2212x1659 — 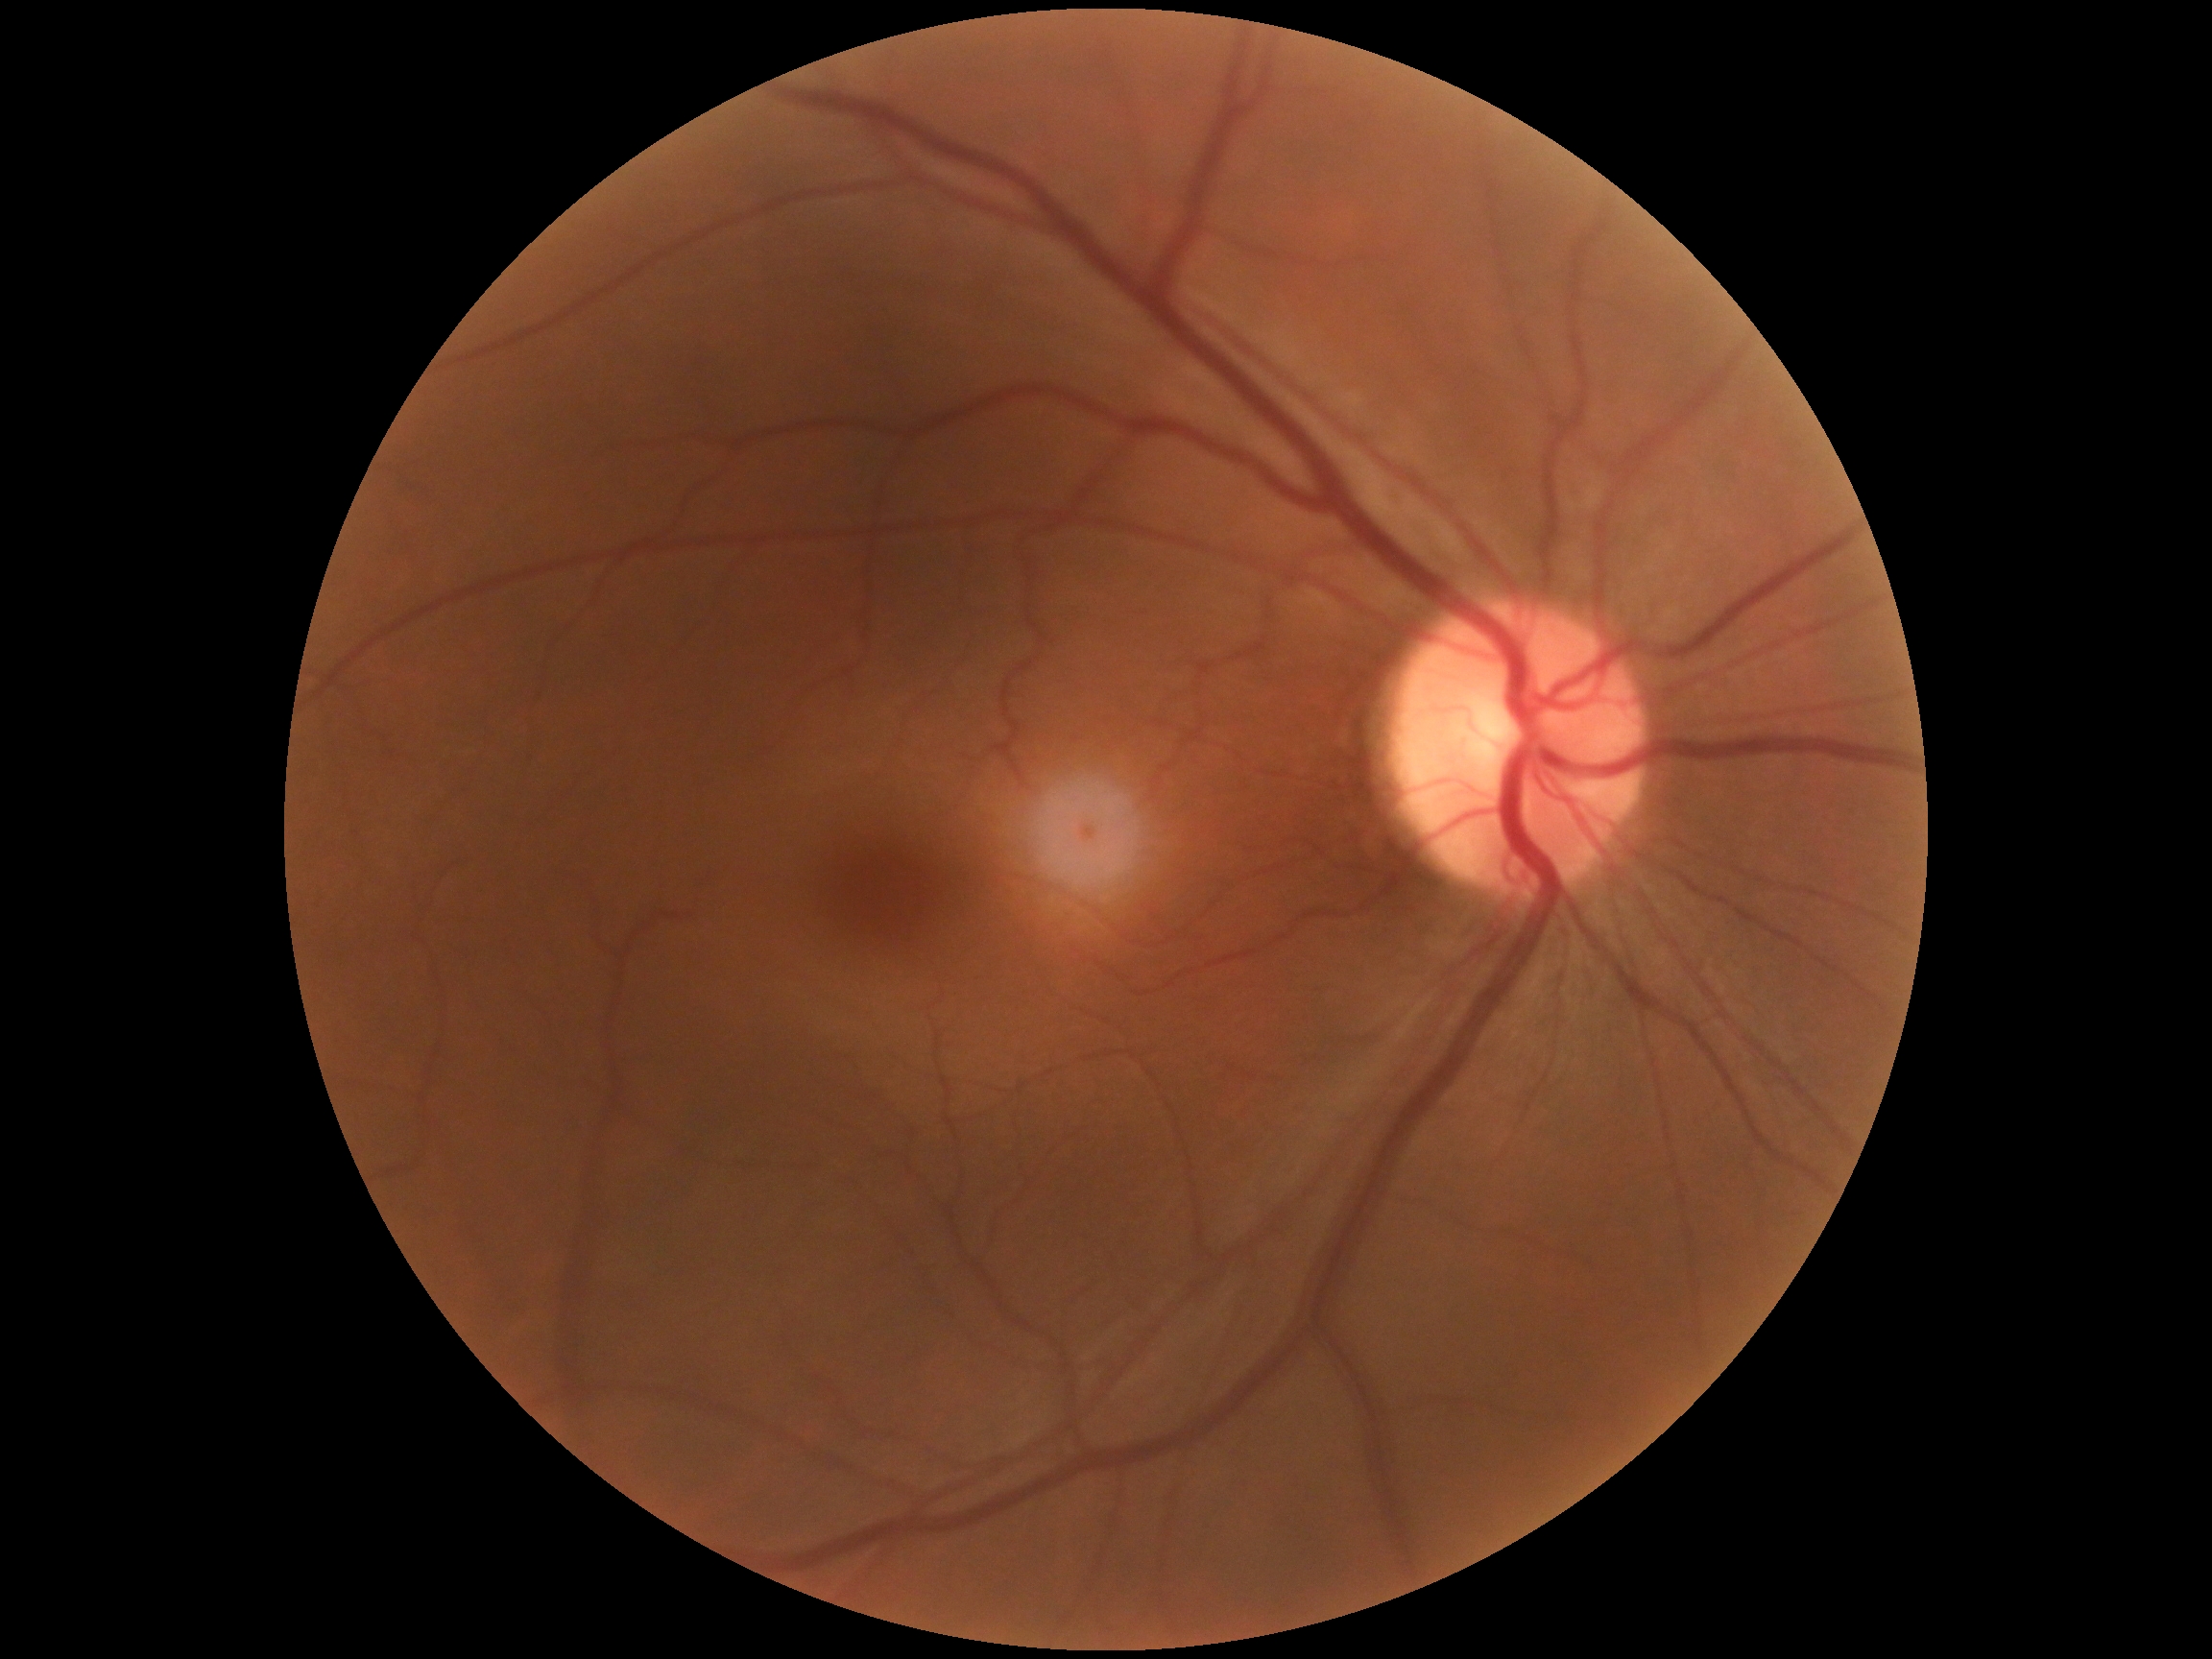 DR impression = no signs of DR
DR severity = 0 — no visible signs of diabetic retinopathy